45° FOV, color fundus photograph, image size 1920x1088 — 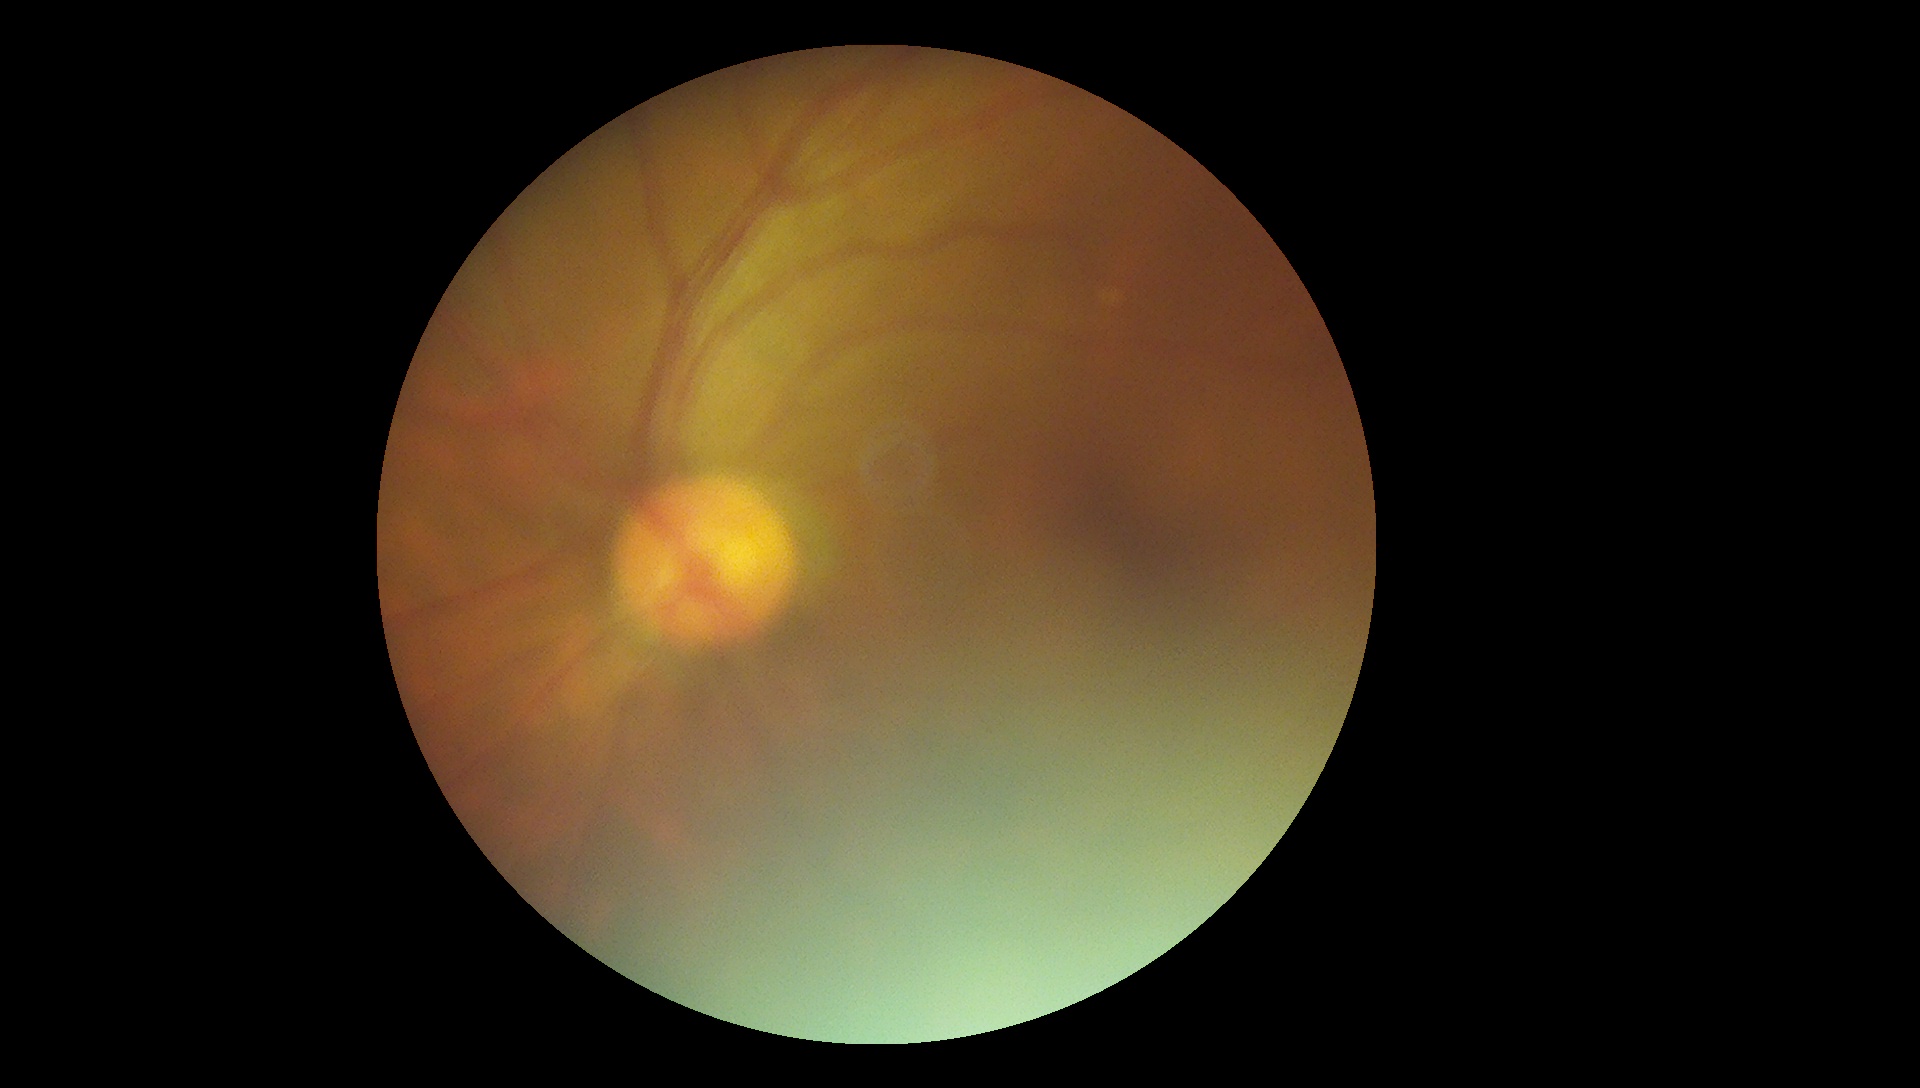

DR stage is grade 0 (no apparent retinopathy).
No DR findings.